Modified Davis classification: 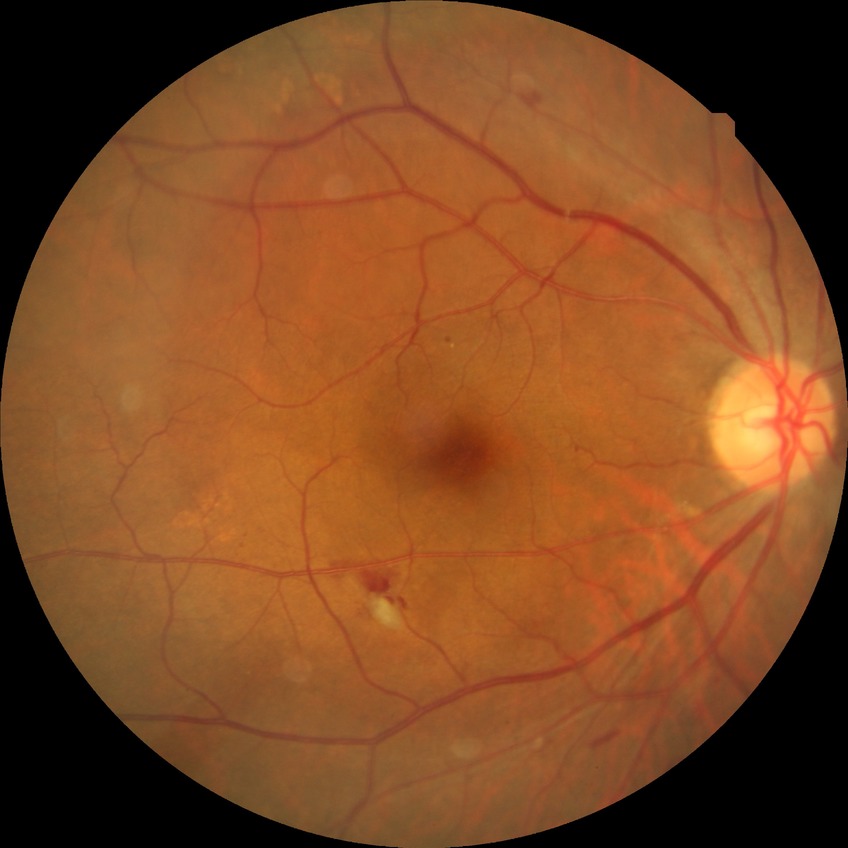

davis_grade: simple diabetic retinopathy